Handheld portable fundus camera image: 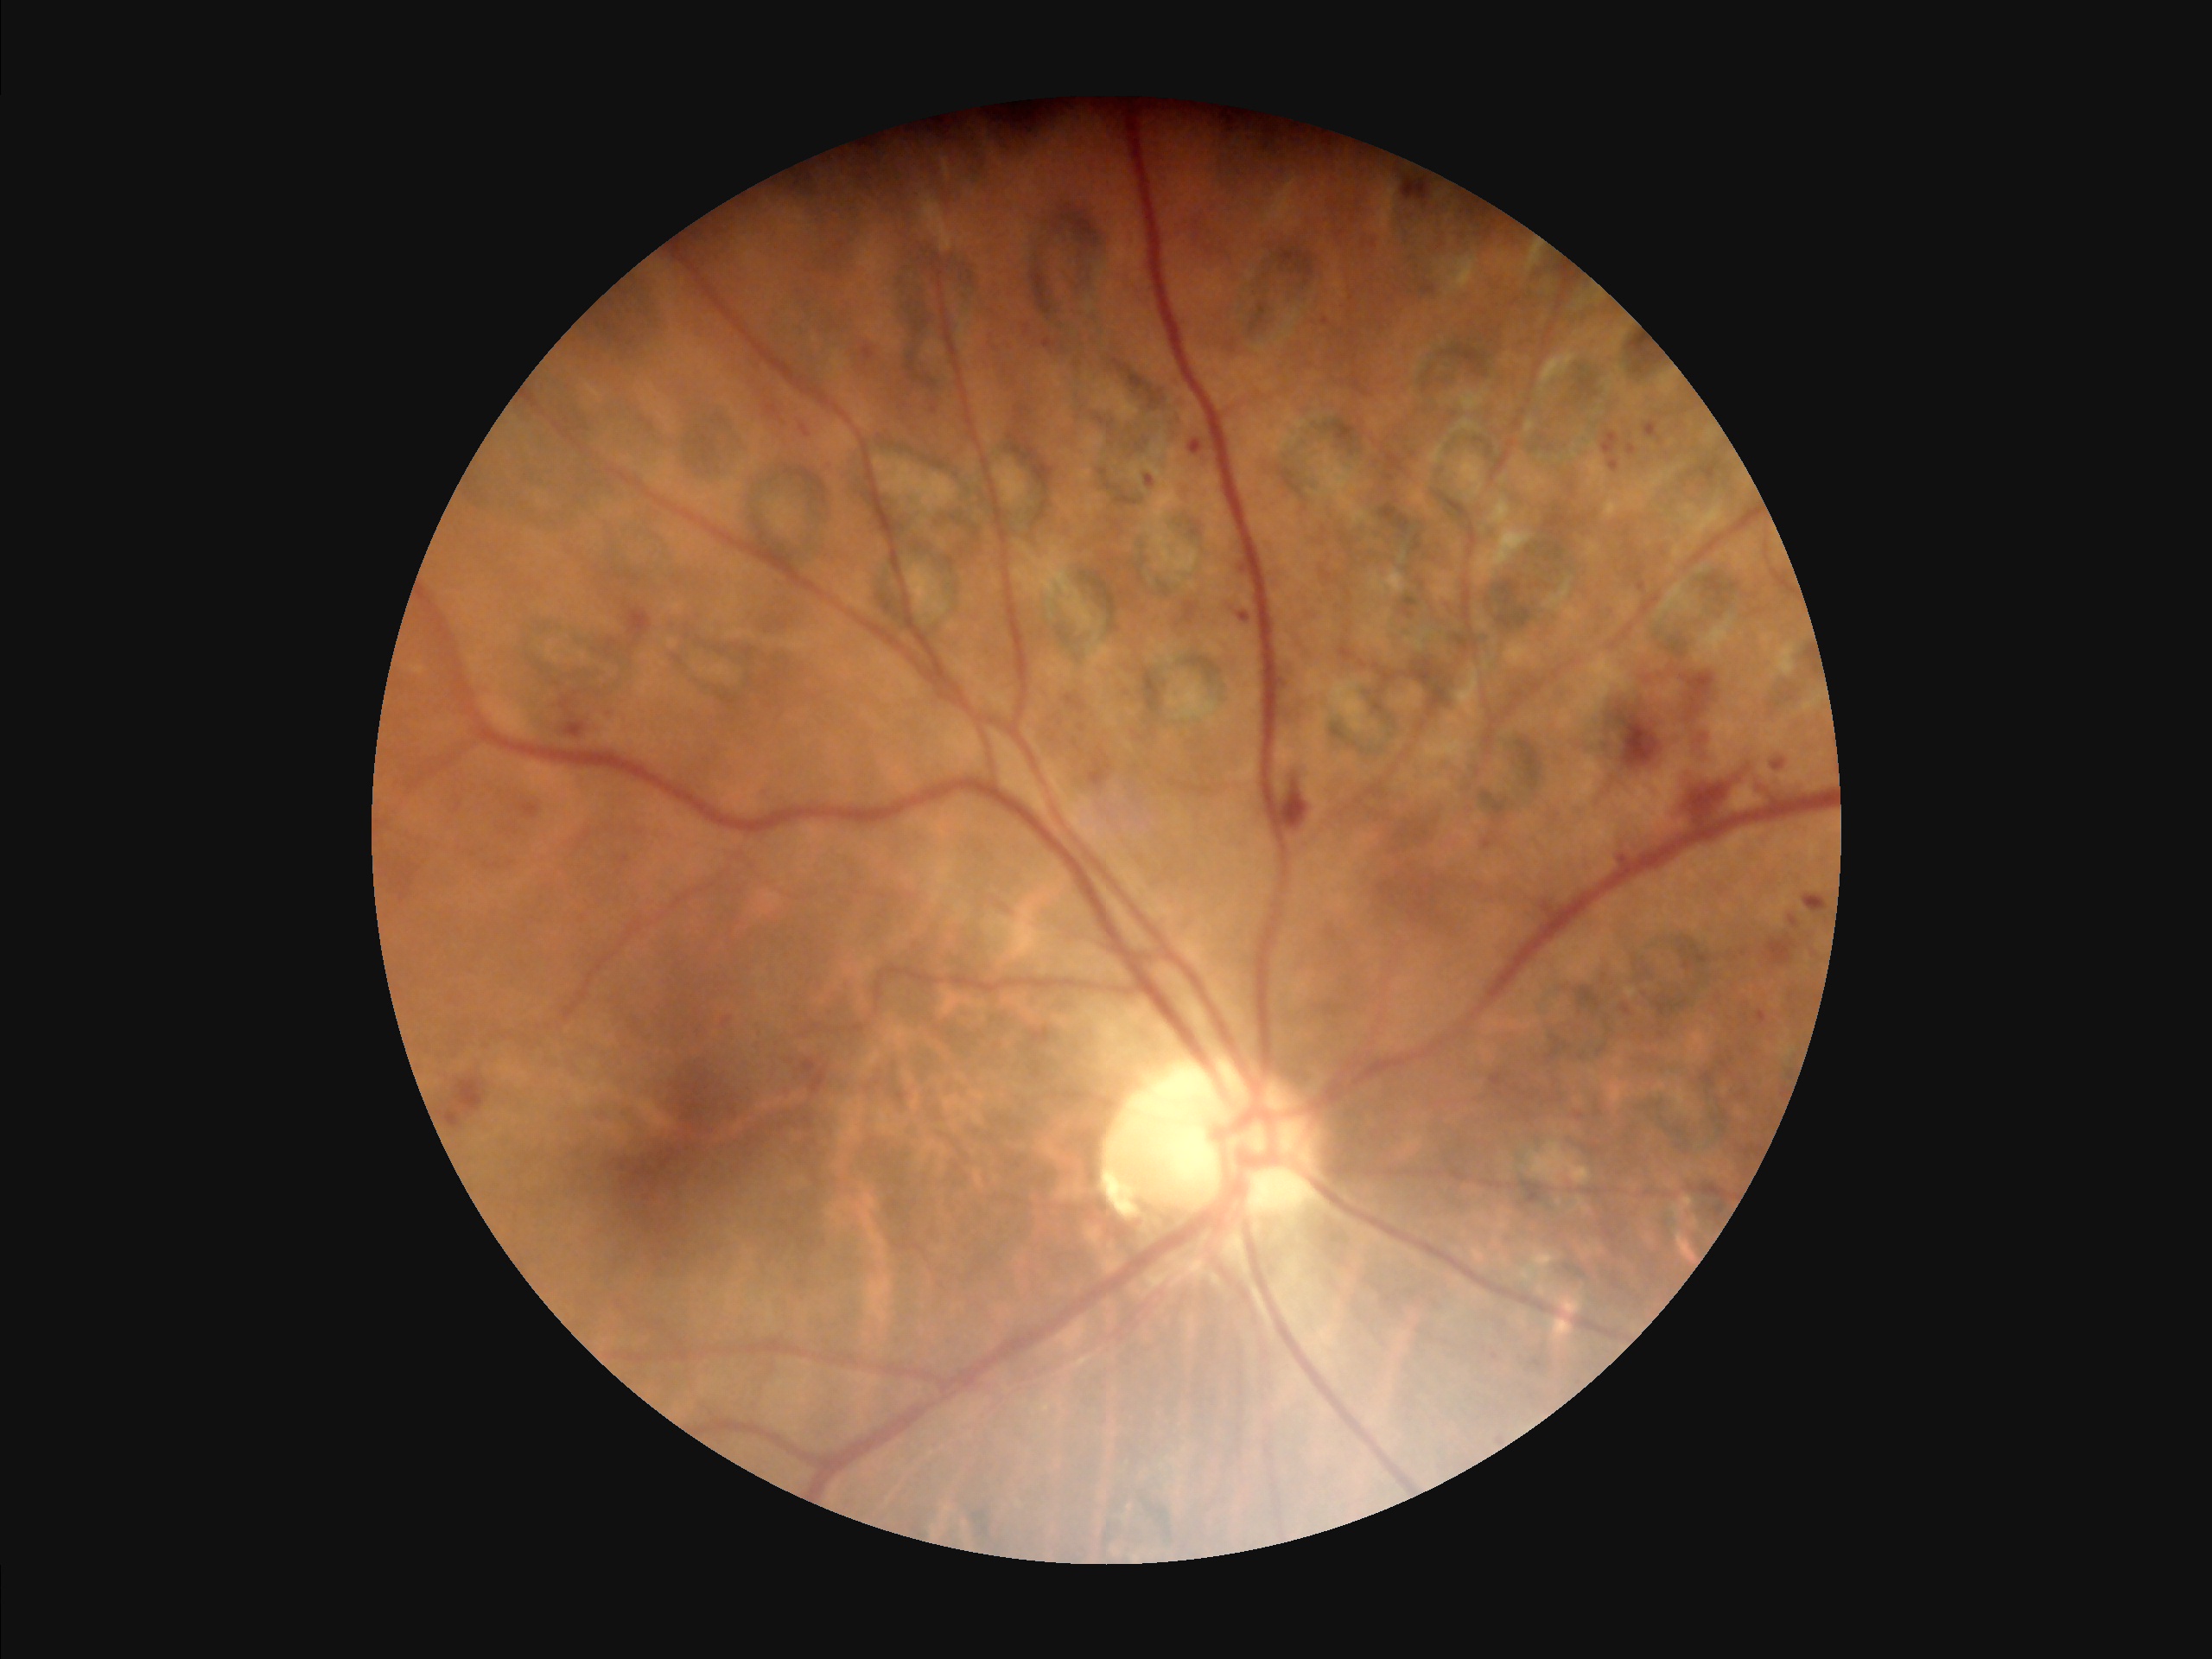
Illumination and color balance are good.
Overall image quality is good.
Adequate contrast for distinguishing structures.
Optic disc, vessels, and background are in focus.